2352x1568px — 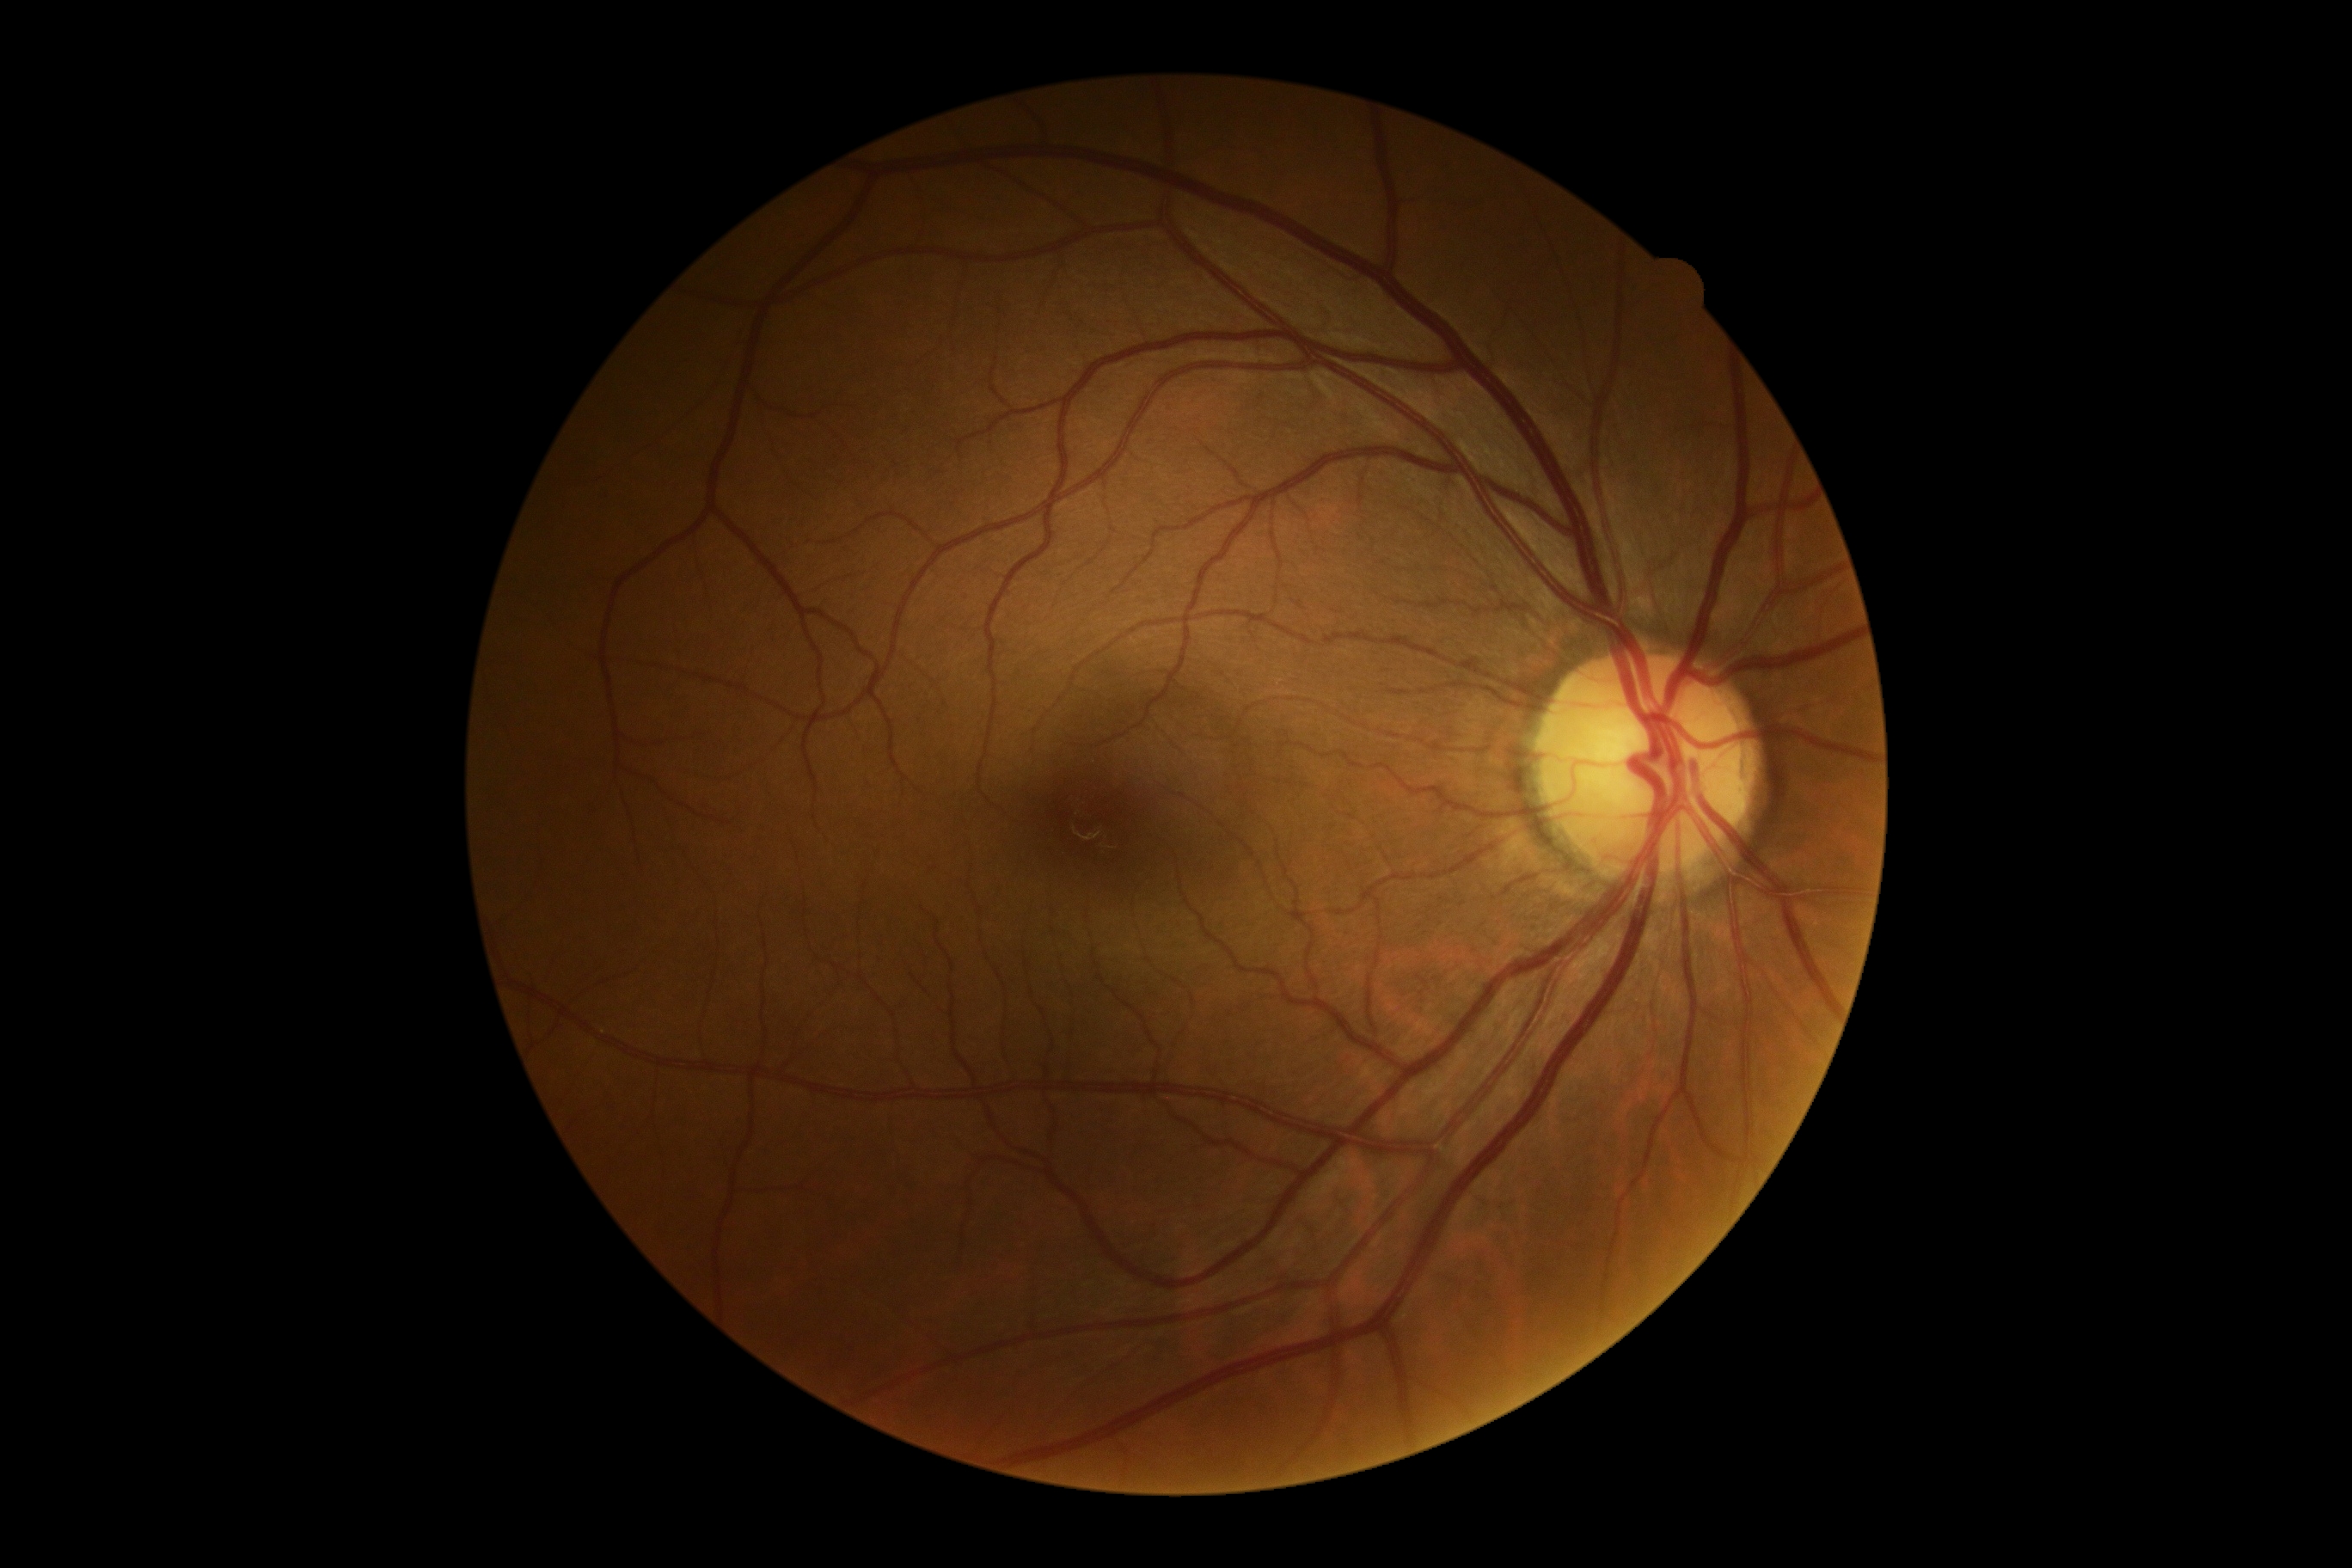
Diabetic retinopathy (DR): grade 0.